640 by 480 pixels; camera: Clarity RetCam 3 (130° FOV); wide-field fundus photograph of an infant.
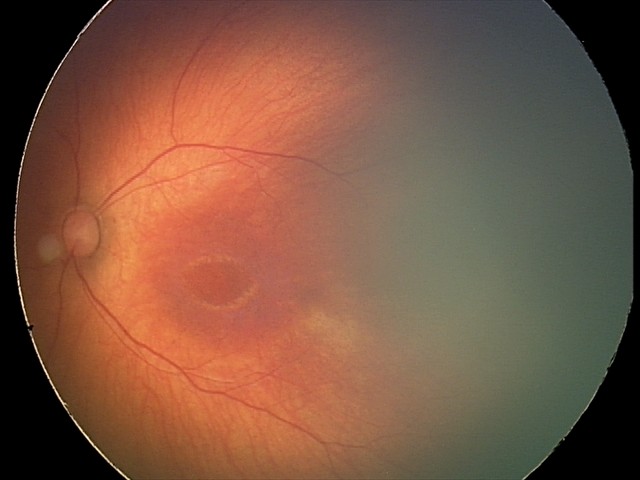 Normal screening examination.